DR severity per modified Davis staging:
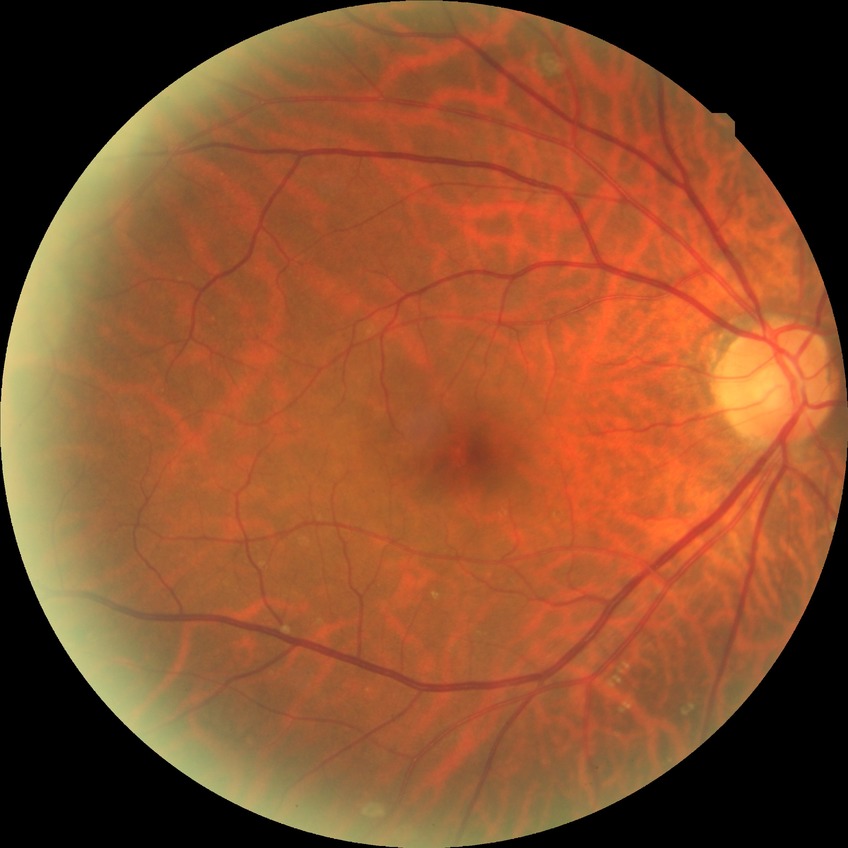 Diabetic retinopathy (DR): NDR (no diabetic retinopathy).